130° field of view (Clarity RetCam 3) · 640 by 480 pixels · infant wide-field fundus photograph — 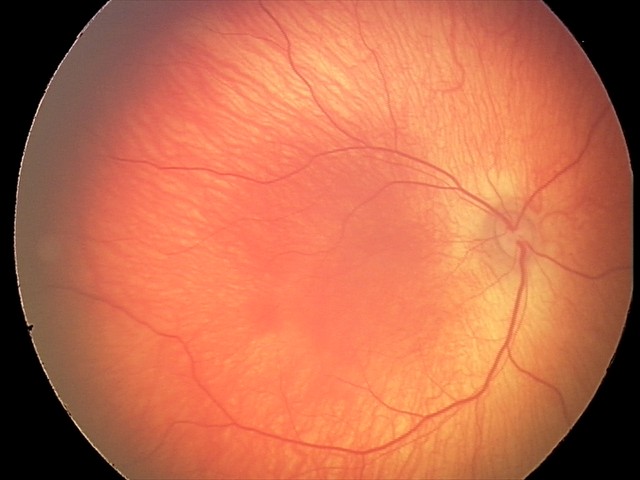

Examination with physiological retinal findings.